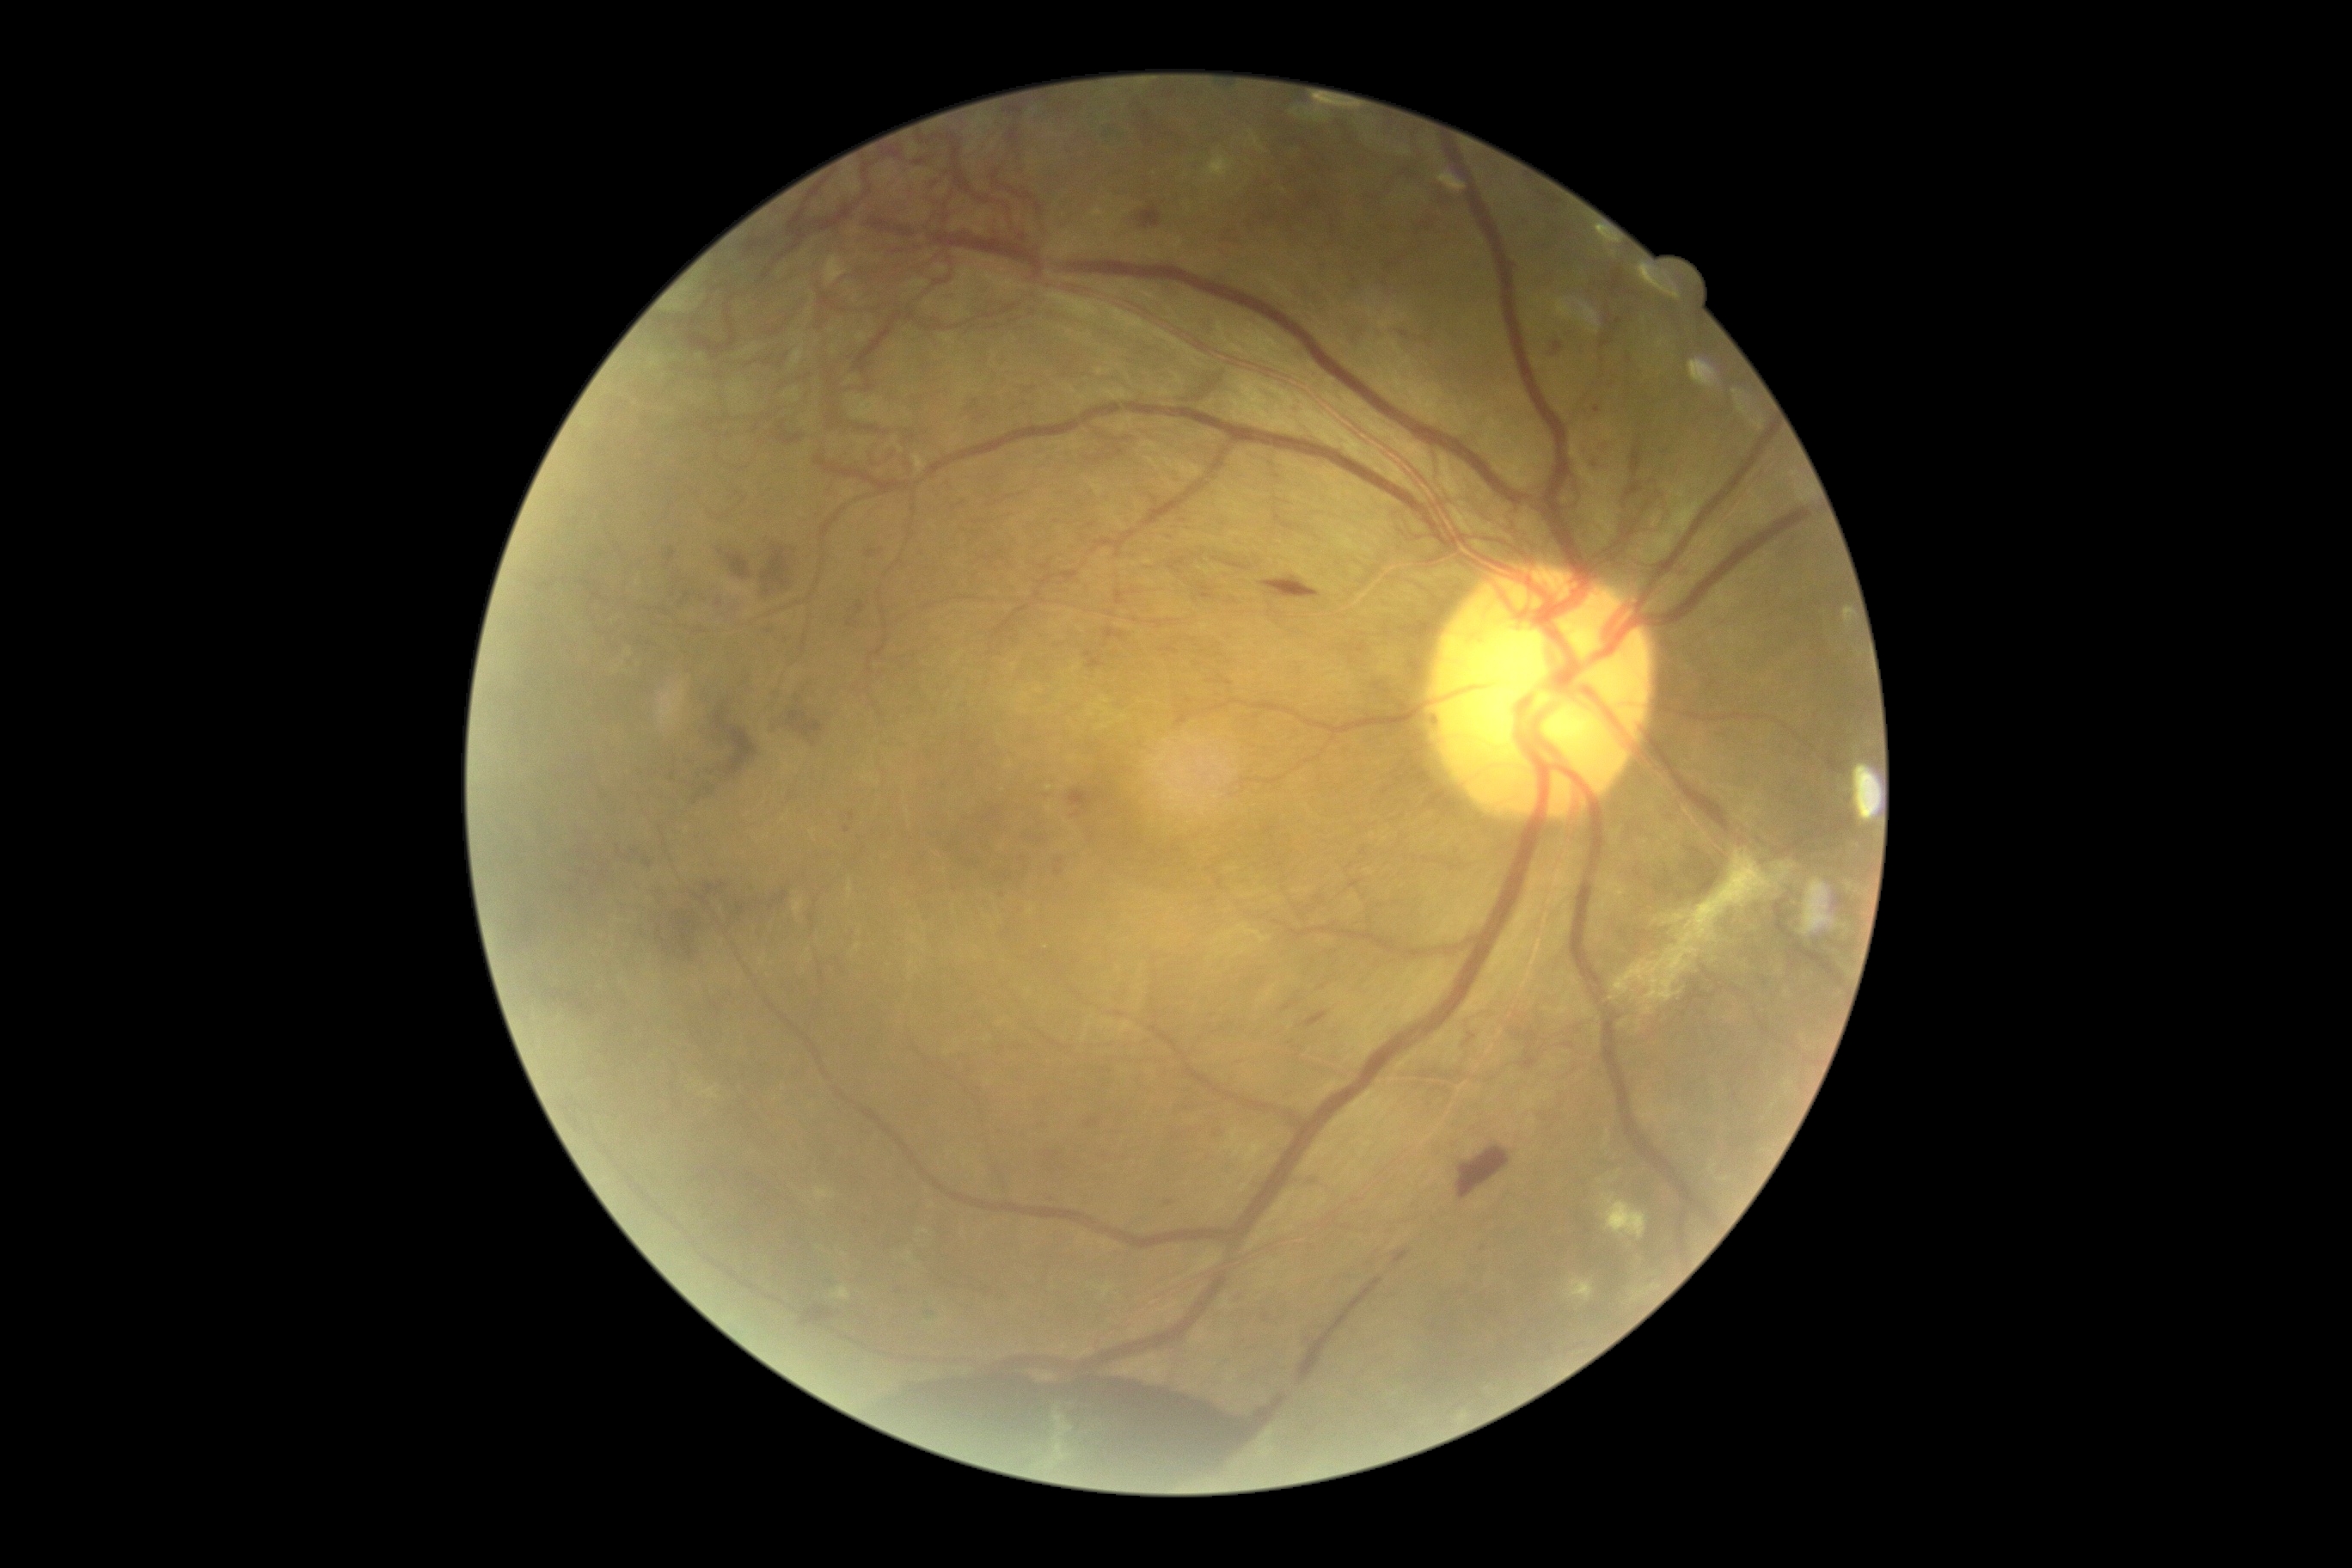
Retinopathy: proliferative diabetic retinopathy (grade 4). Hemorrhages are present, including at Rect(1086, 1120, 1099, 1129) | Rect(850, 812, 855, 821) | Rect(1299, 1278, 1383, 1385) | Rect(1519, 216, 1533, 231) | Rect(854, 1371, 1285, 1485) | Rect(847, 599, 867, 627) | Rect(800, 1306, 835, 1326) | Rect(1304, 1012, 1328, 1029) | Rect(1263, 577, 1321, 599) | Rect(1223, 561, 1247, 570) | Rect(716, 592, 749, 622) | Rect(682, 587, 699, 603) | Rect(1602, 341, 1610, 350) | Rect(769, 697, 835, 740) | Rect(1607, 374, 1619, 393). Small hemorrhages near (846; 831) | (1619; 322) | (1056; 1154) | (1170; 1204). Hard exudates identified at Rect(1631, 1283, 1660, 1302) | Rect(1567, 1278, 1595, 1302) | Rect(1602, 1194, 1646, 1240) | Rect(824, 255, 848, 286) | Rect(914, 455, 926, 474). Small hard exudates near (900; 449). No soft exudates identified. No microaneurysms identified.